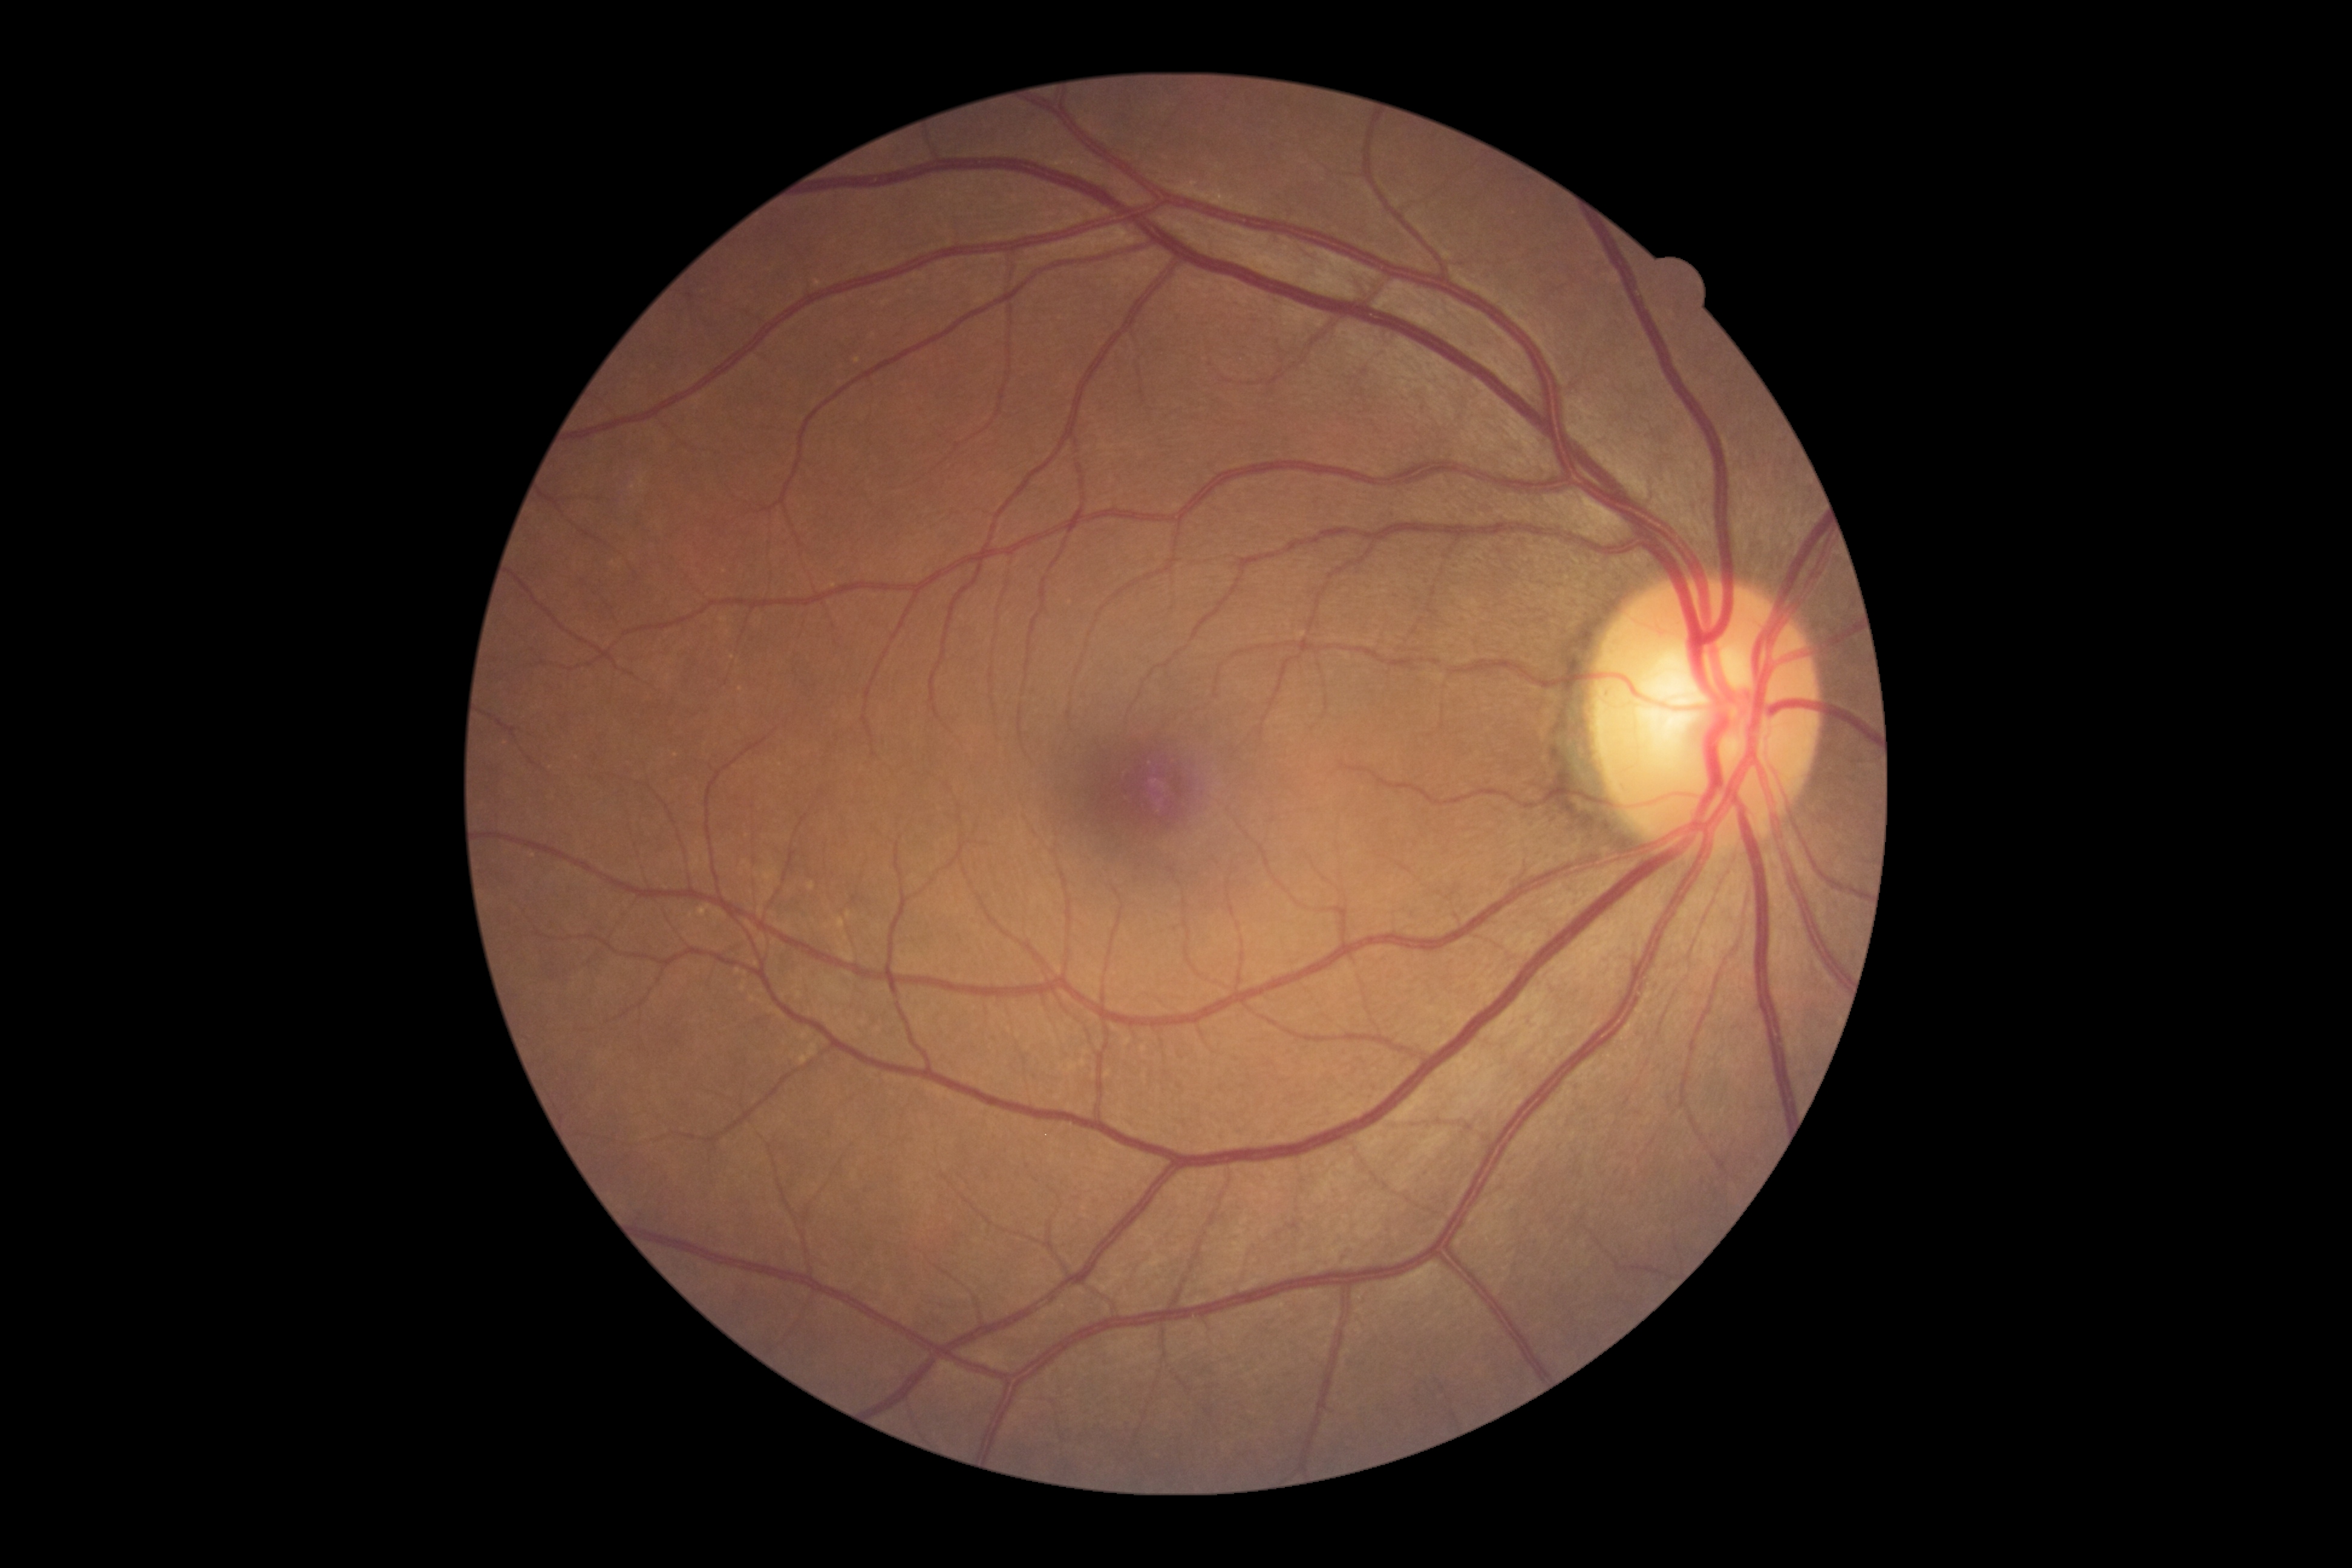 * diabetic retinopathy severity: no apparent retinopathy (grade 0) — no visible signs of diabetic retinopathy